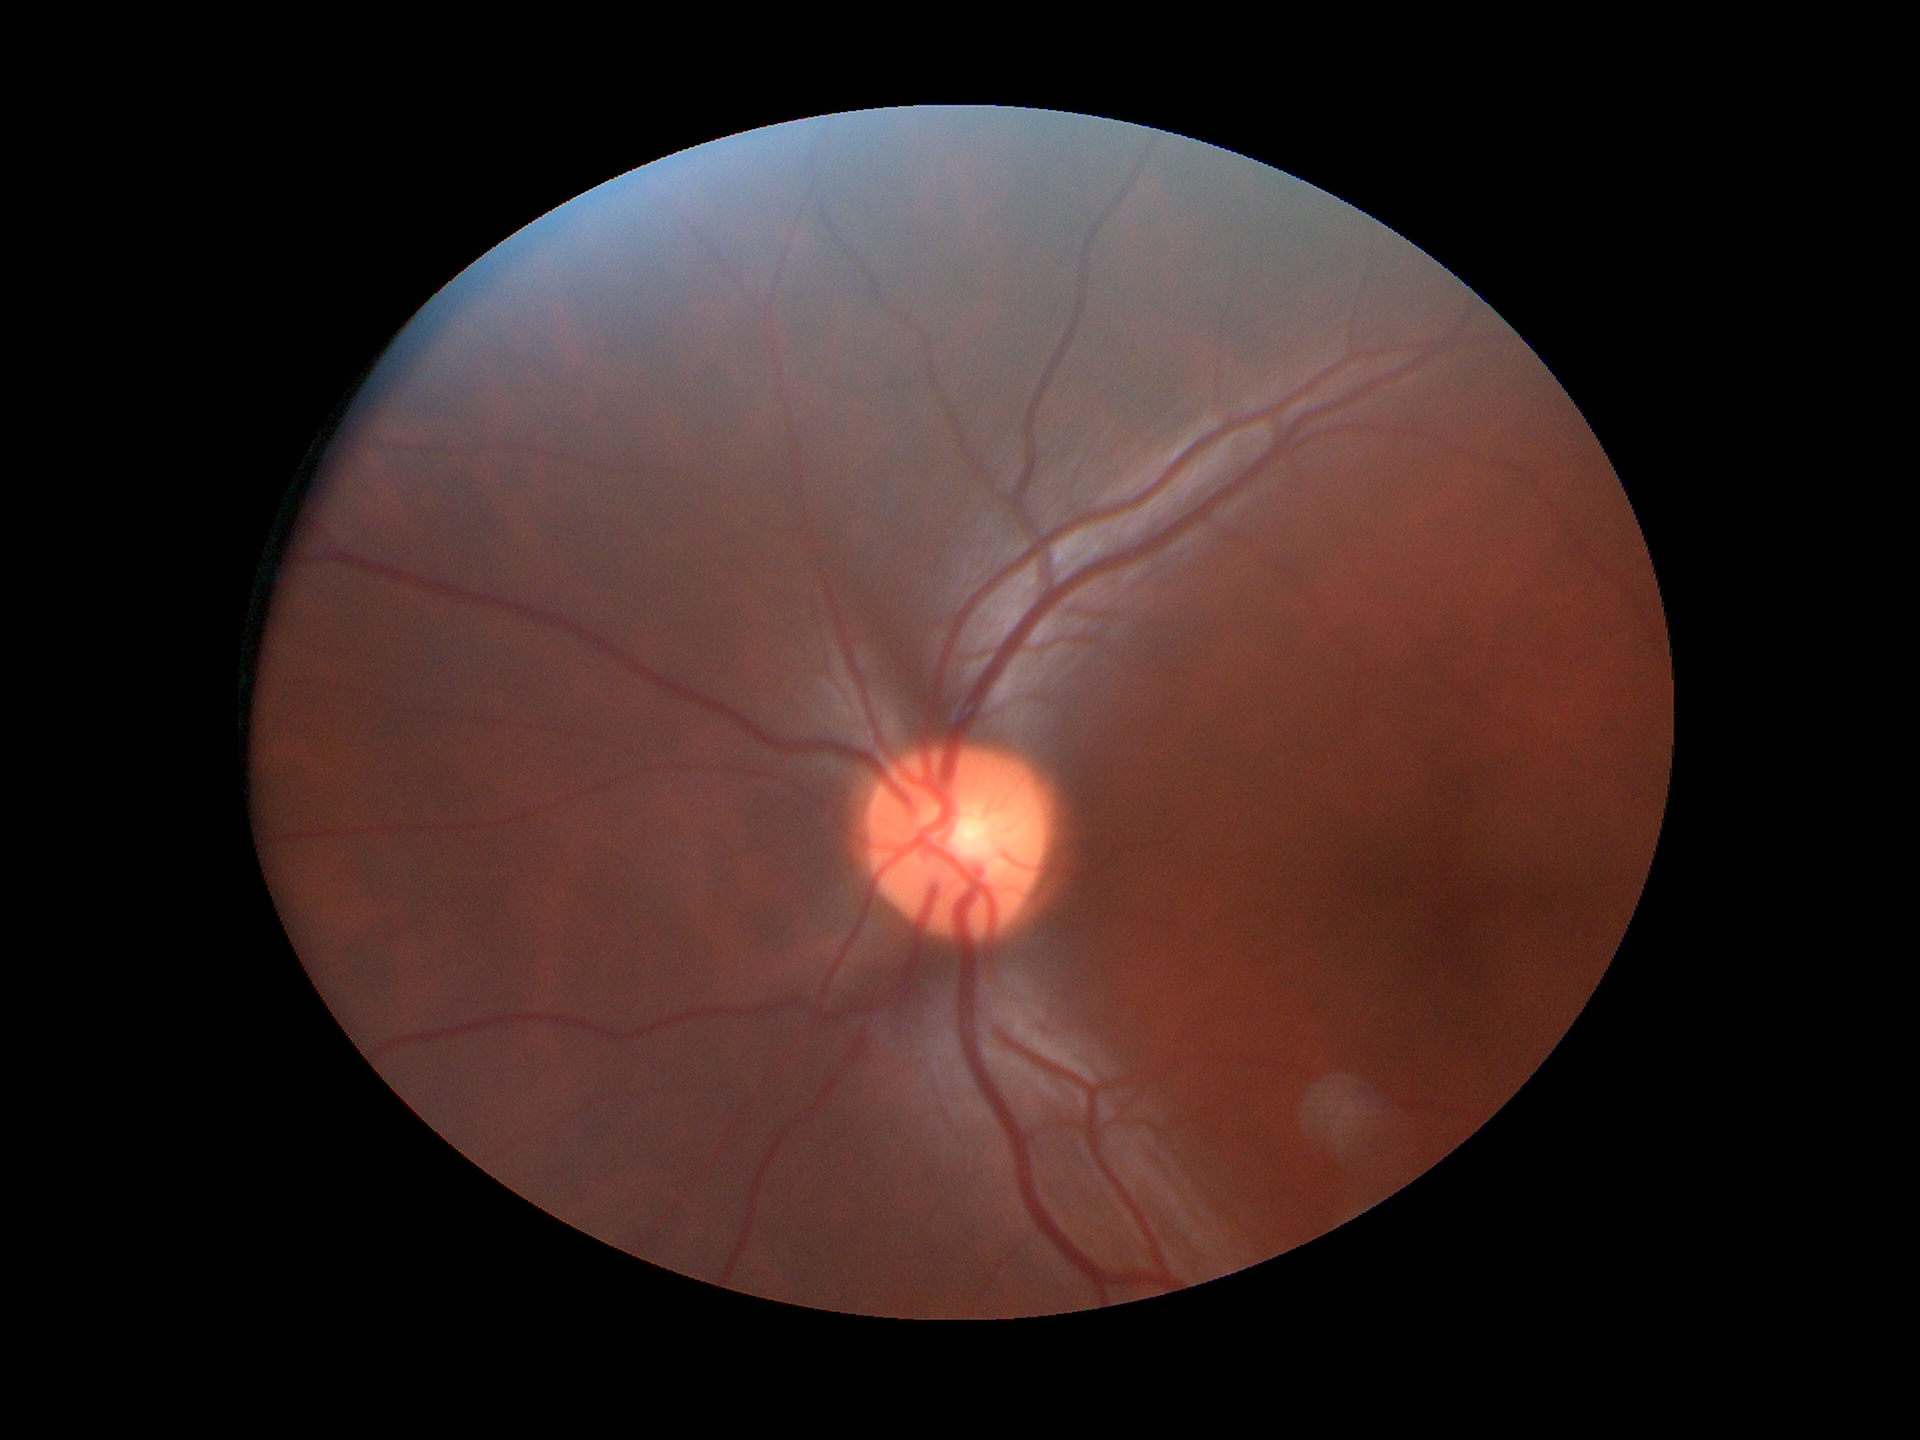 No evidence of glaucoma.
Vertical cup-disc ratio is 0.47.
Horizontal cup-to-disc ratio is 0.50.